Image size 2346x1568 — 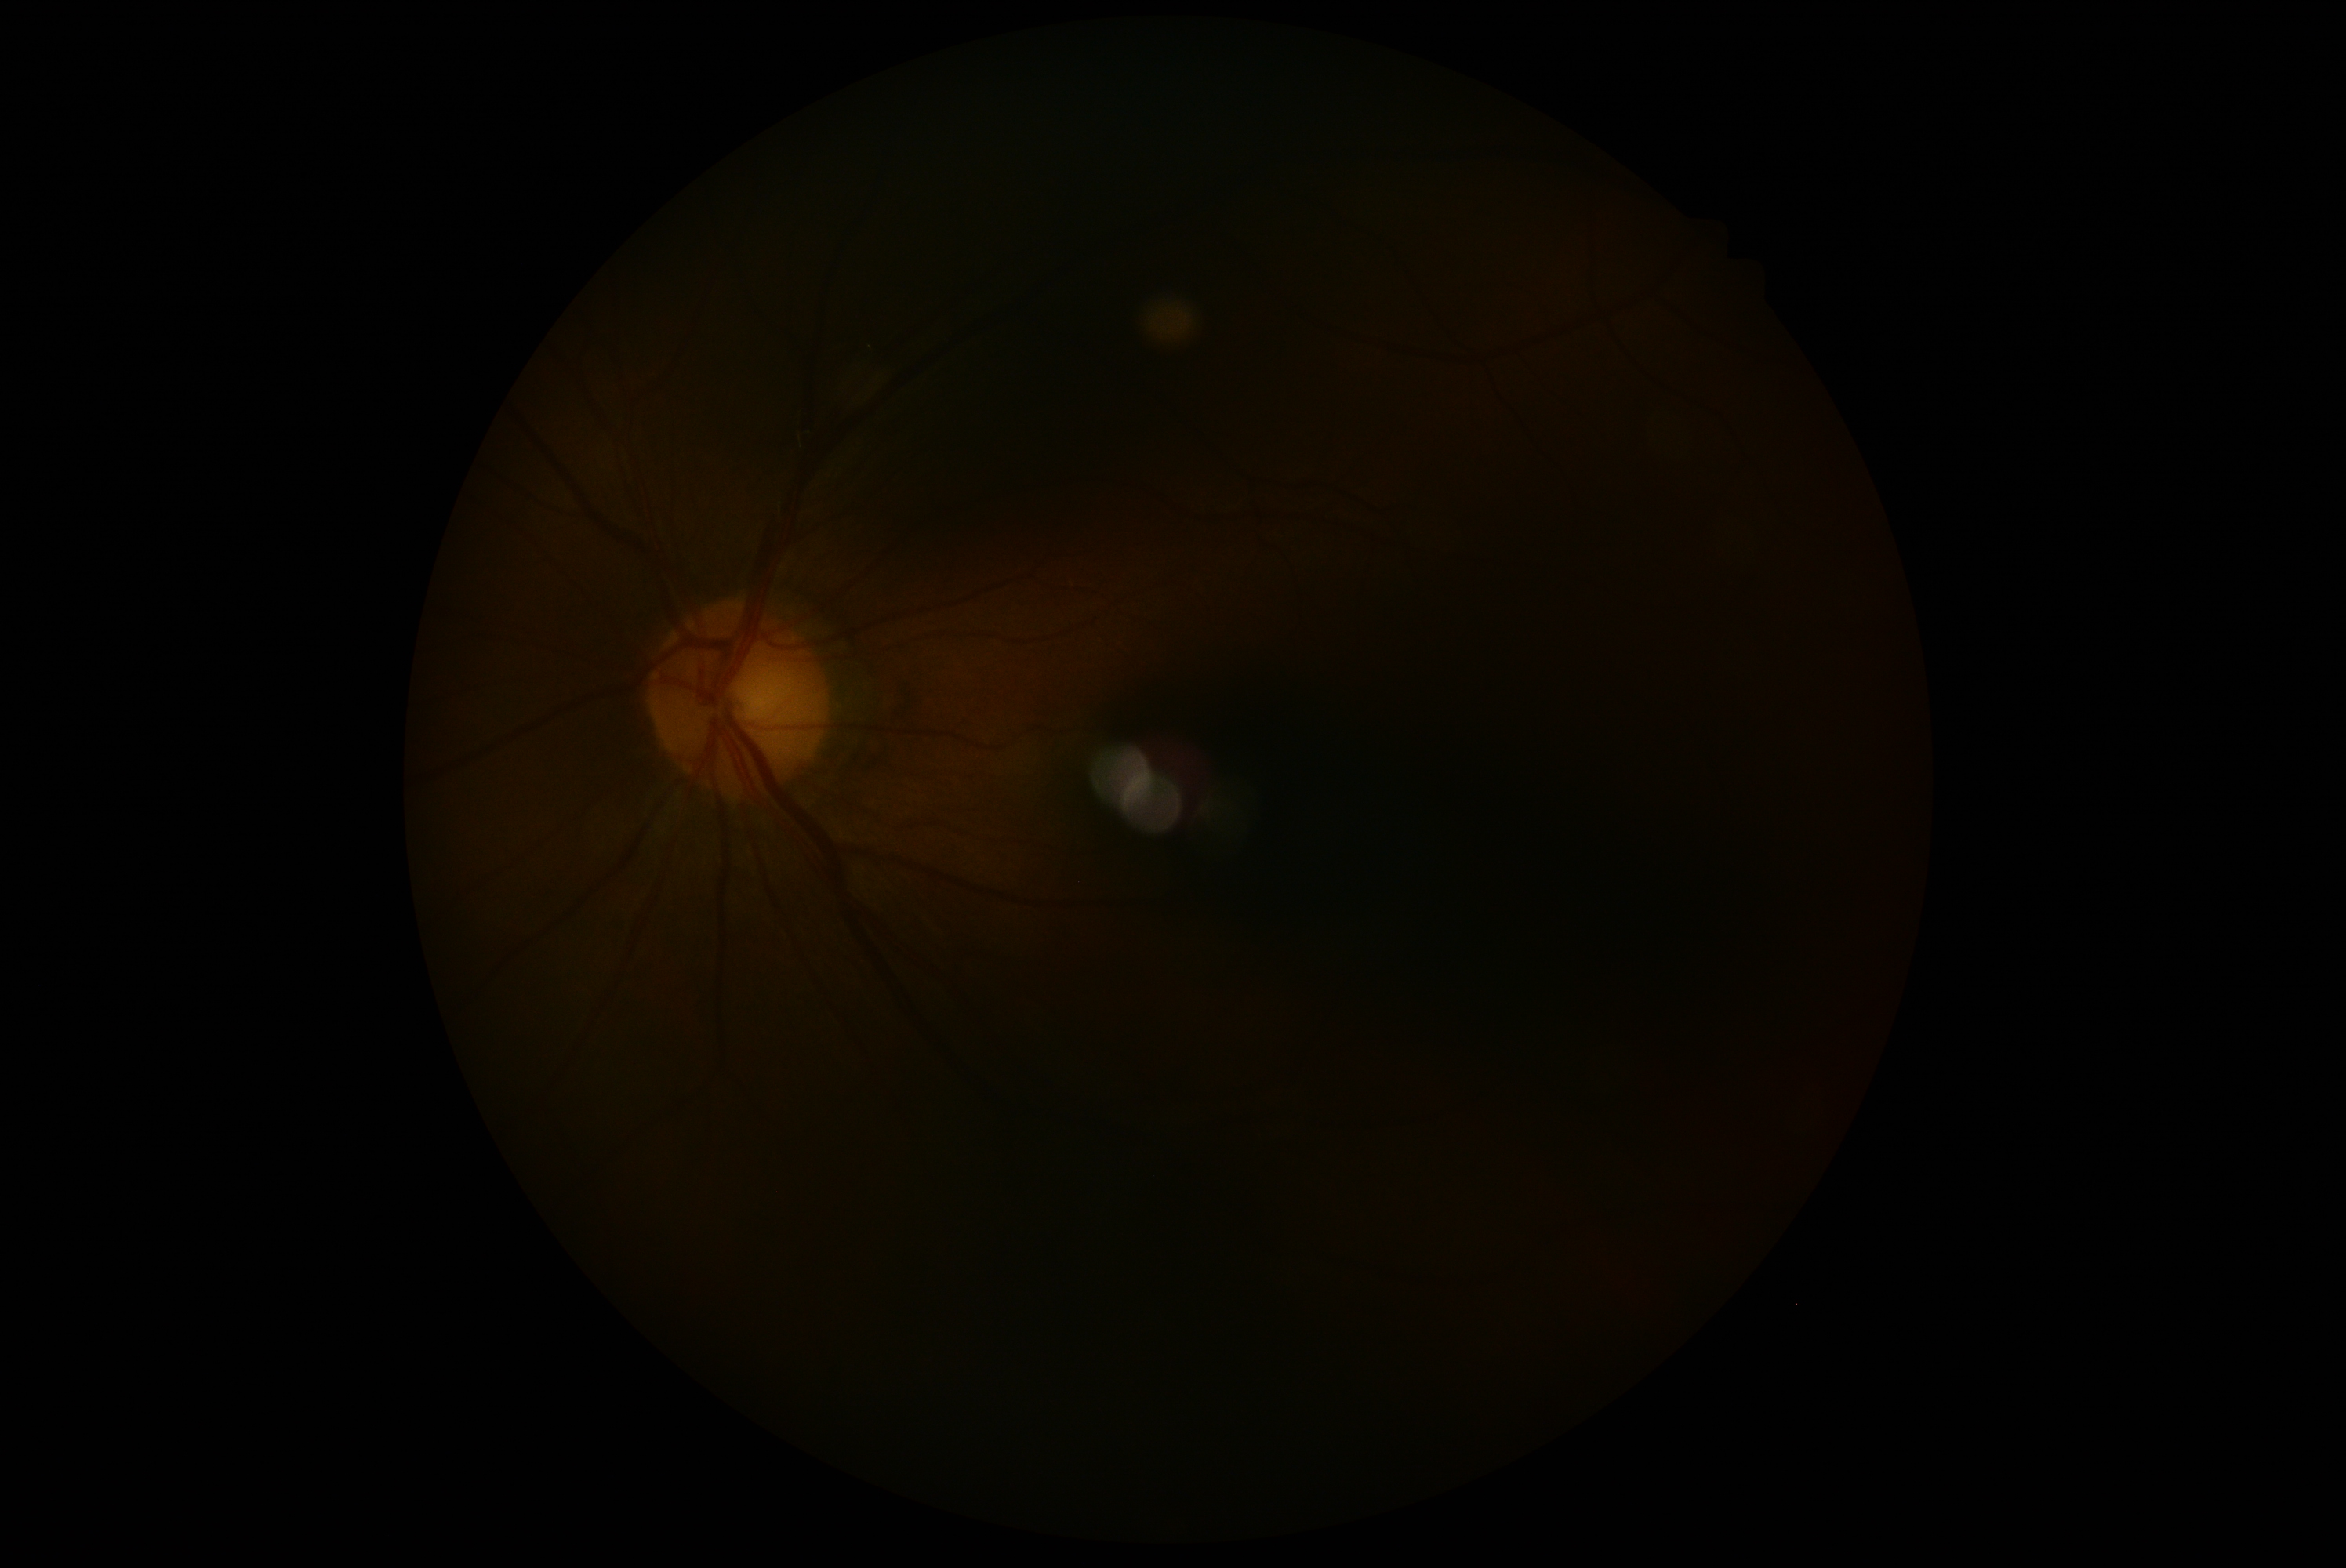 Diabetic retinopathy: ungradable due to poor image quality.